Retinal fundus photograph; 1971 by 1876 pixels.
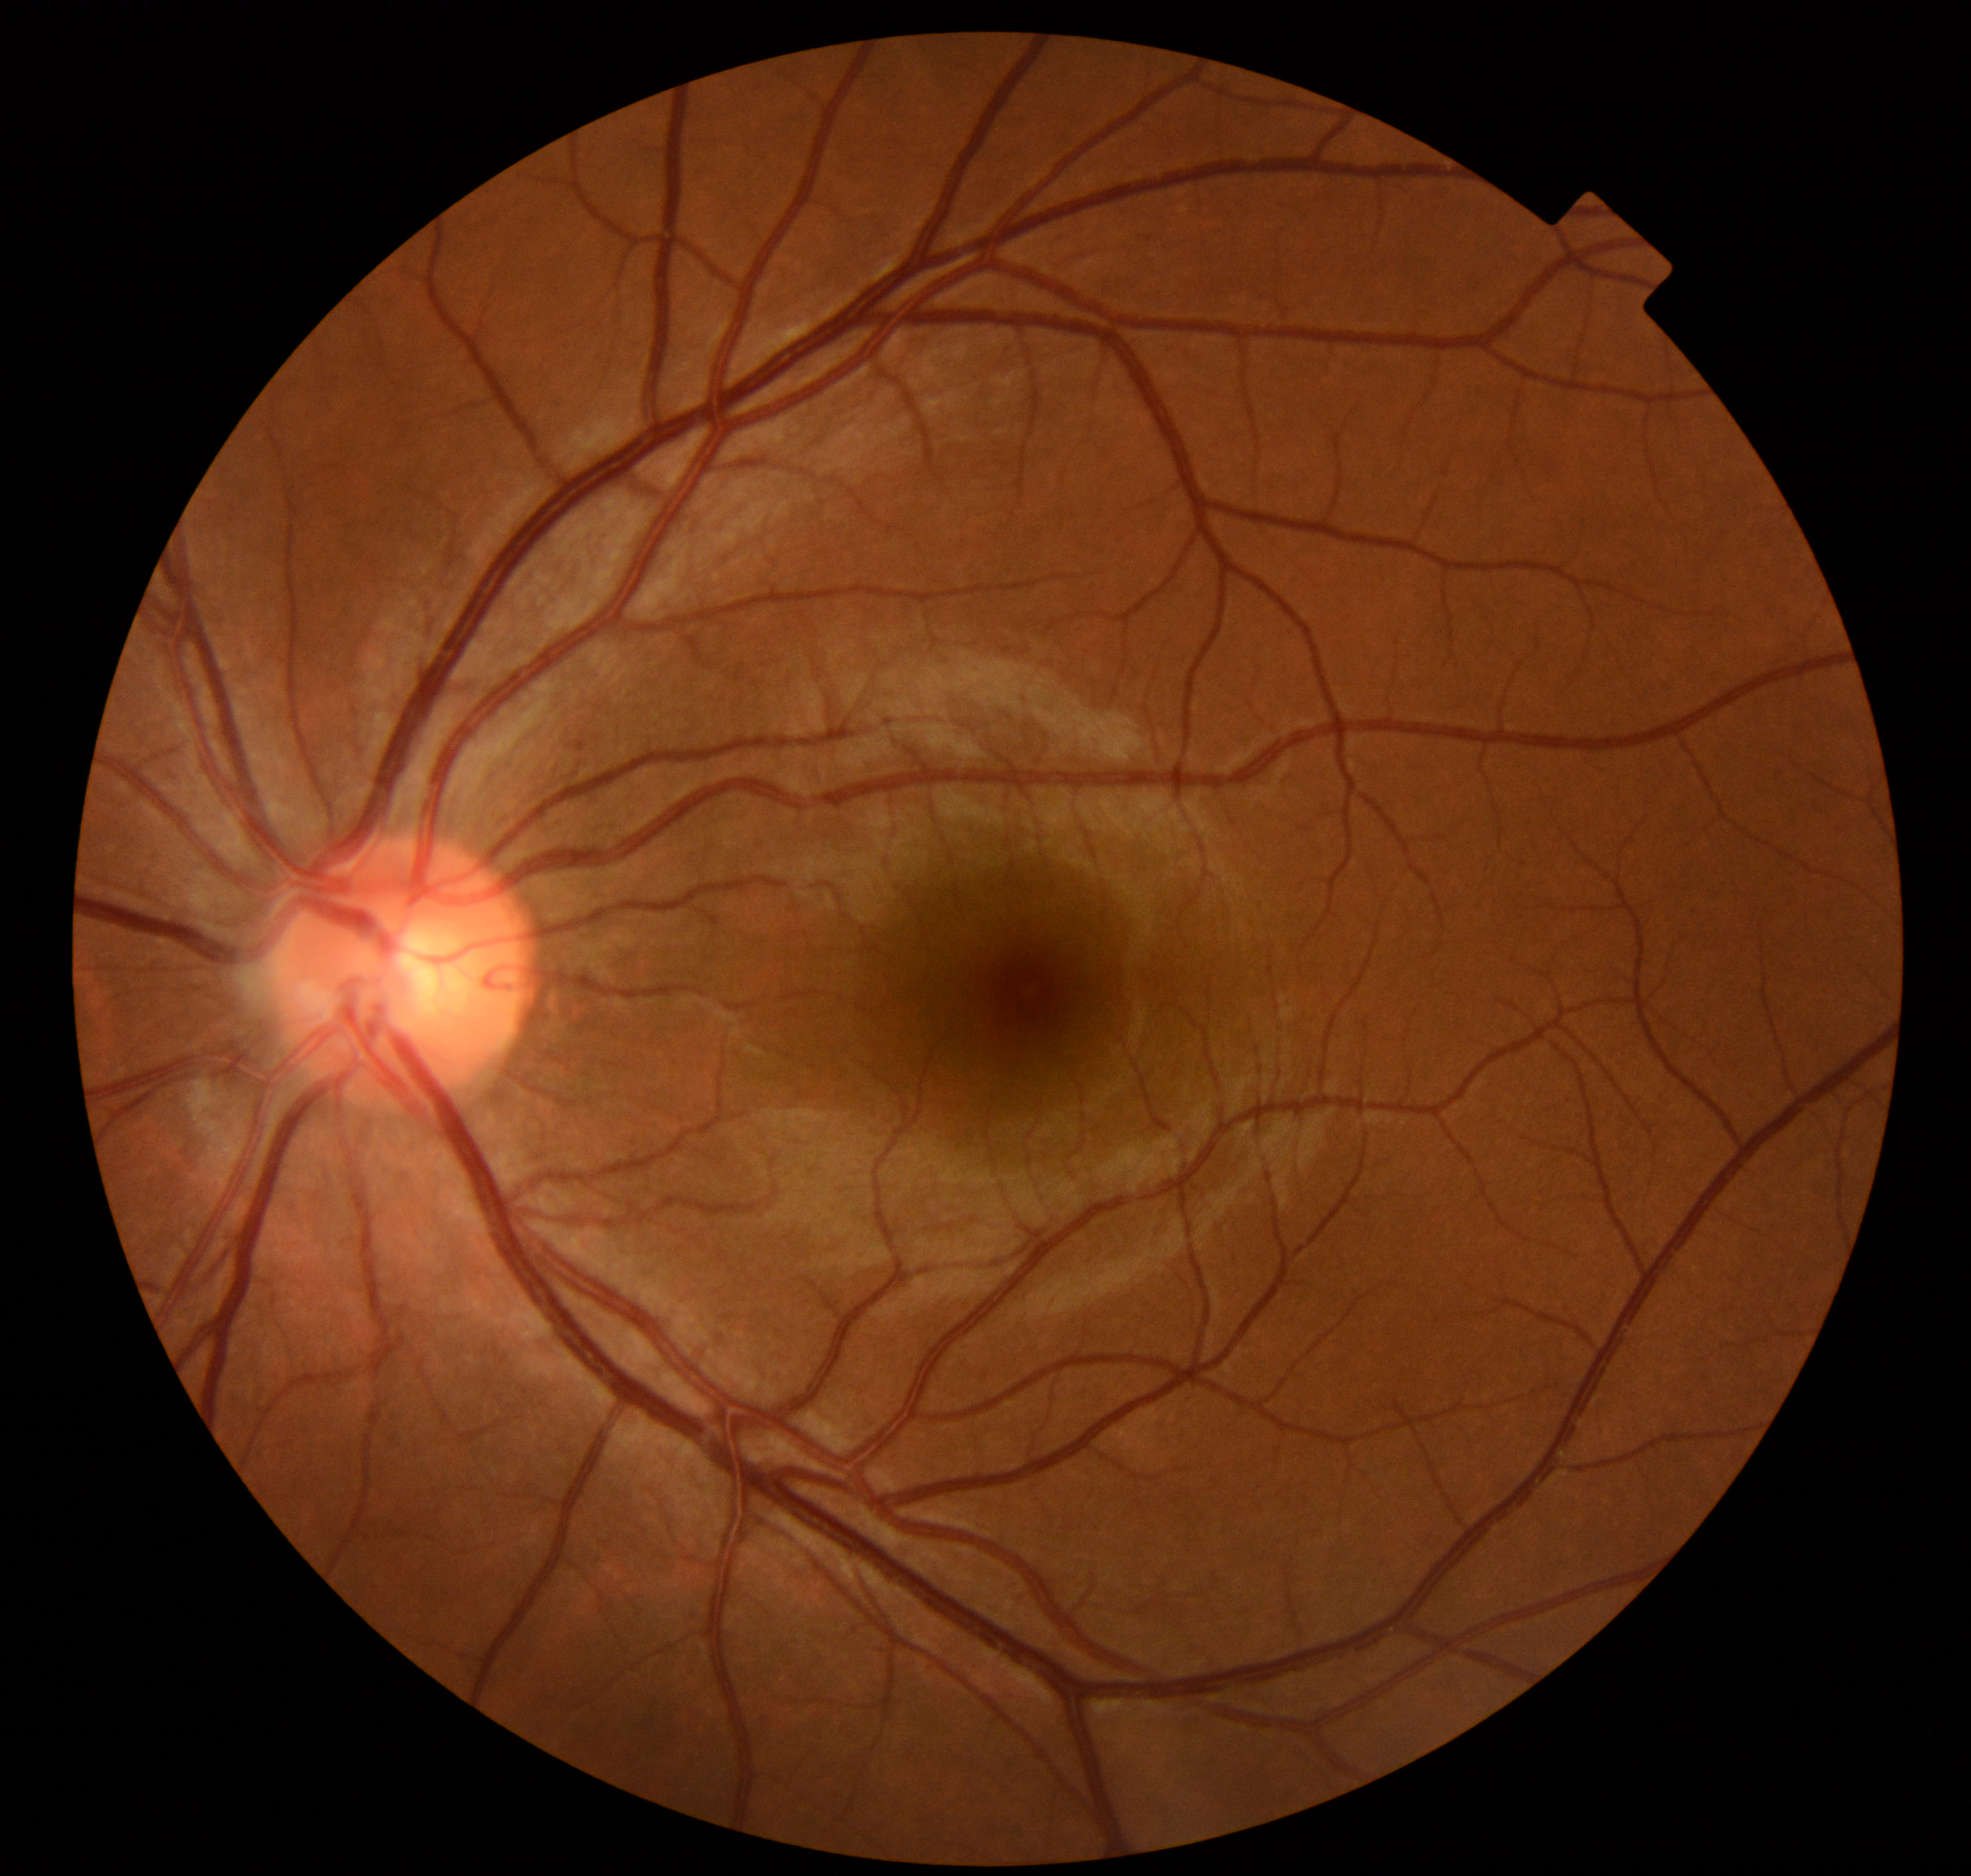

Diagnosis: normal.